45° field of view. Camera: NIDEK AFC-230. 848 x 848 pixels. Without pupil dilation. Posterior pole photograph
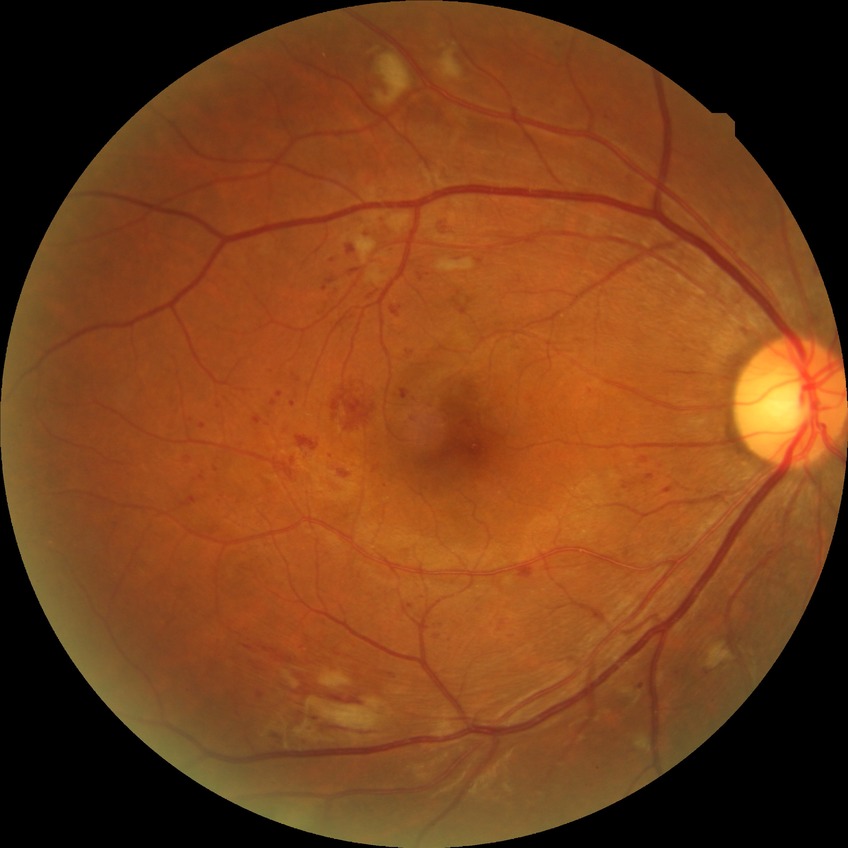

Diabetic retinopathy (DR) is pre-proliferative diabetic retinopathy (PPDR). DR class: non-proliferative diabetic retinopathy.